Nonmydriatic fundus photograph: 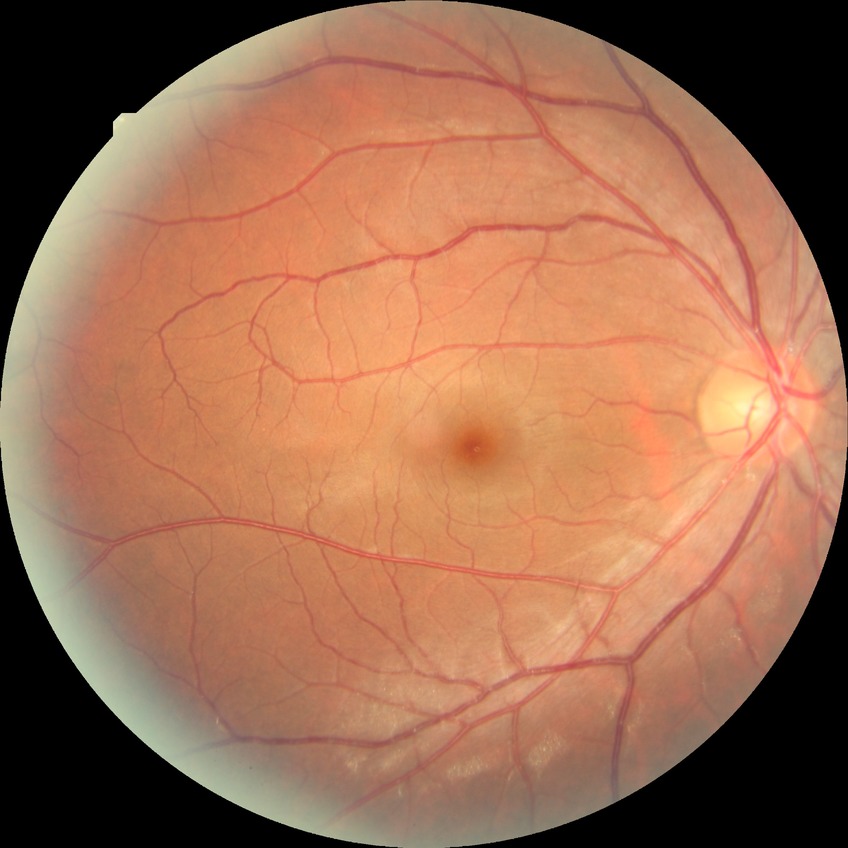

DR severity is NDR.